Retinal fundus photograph.
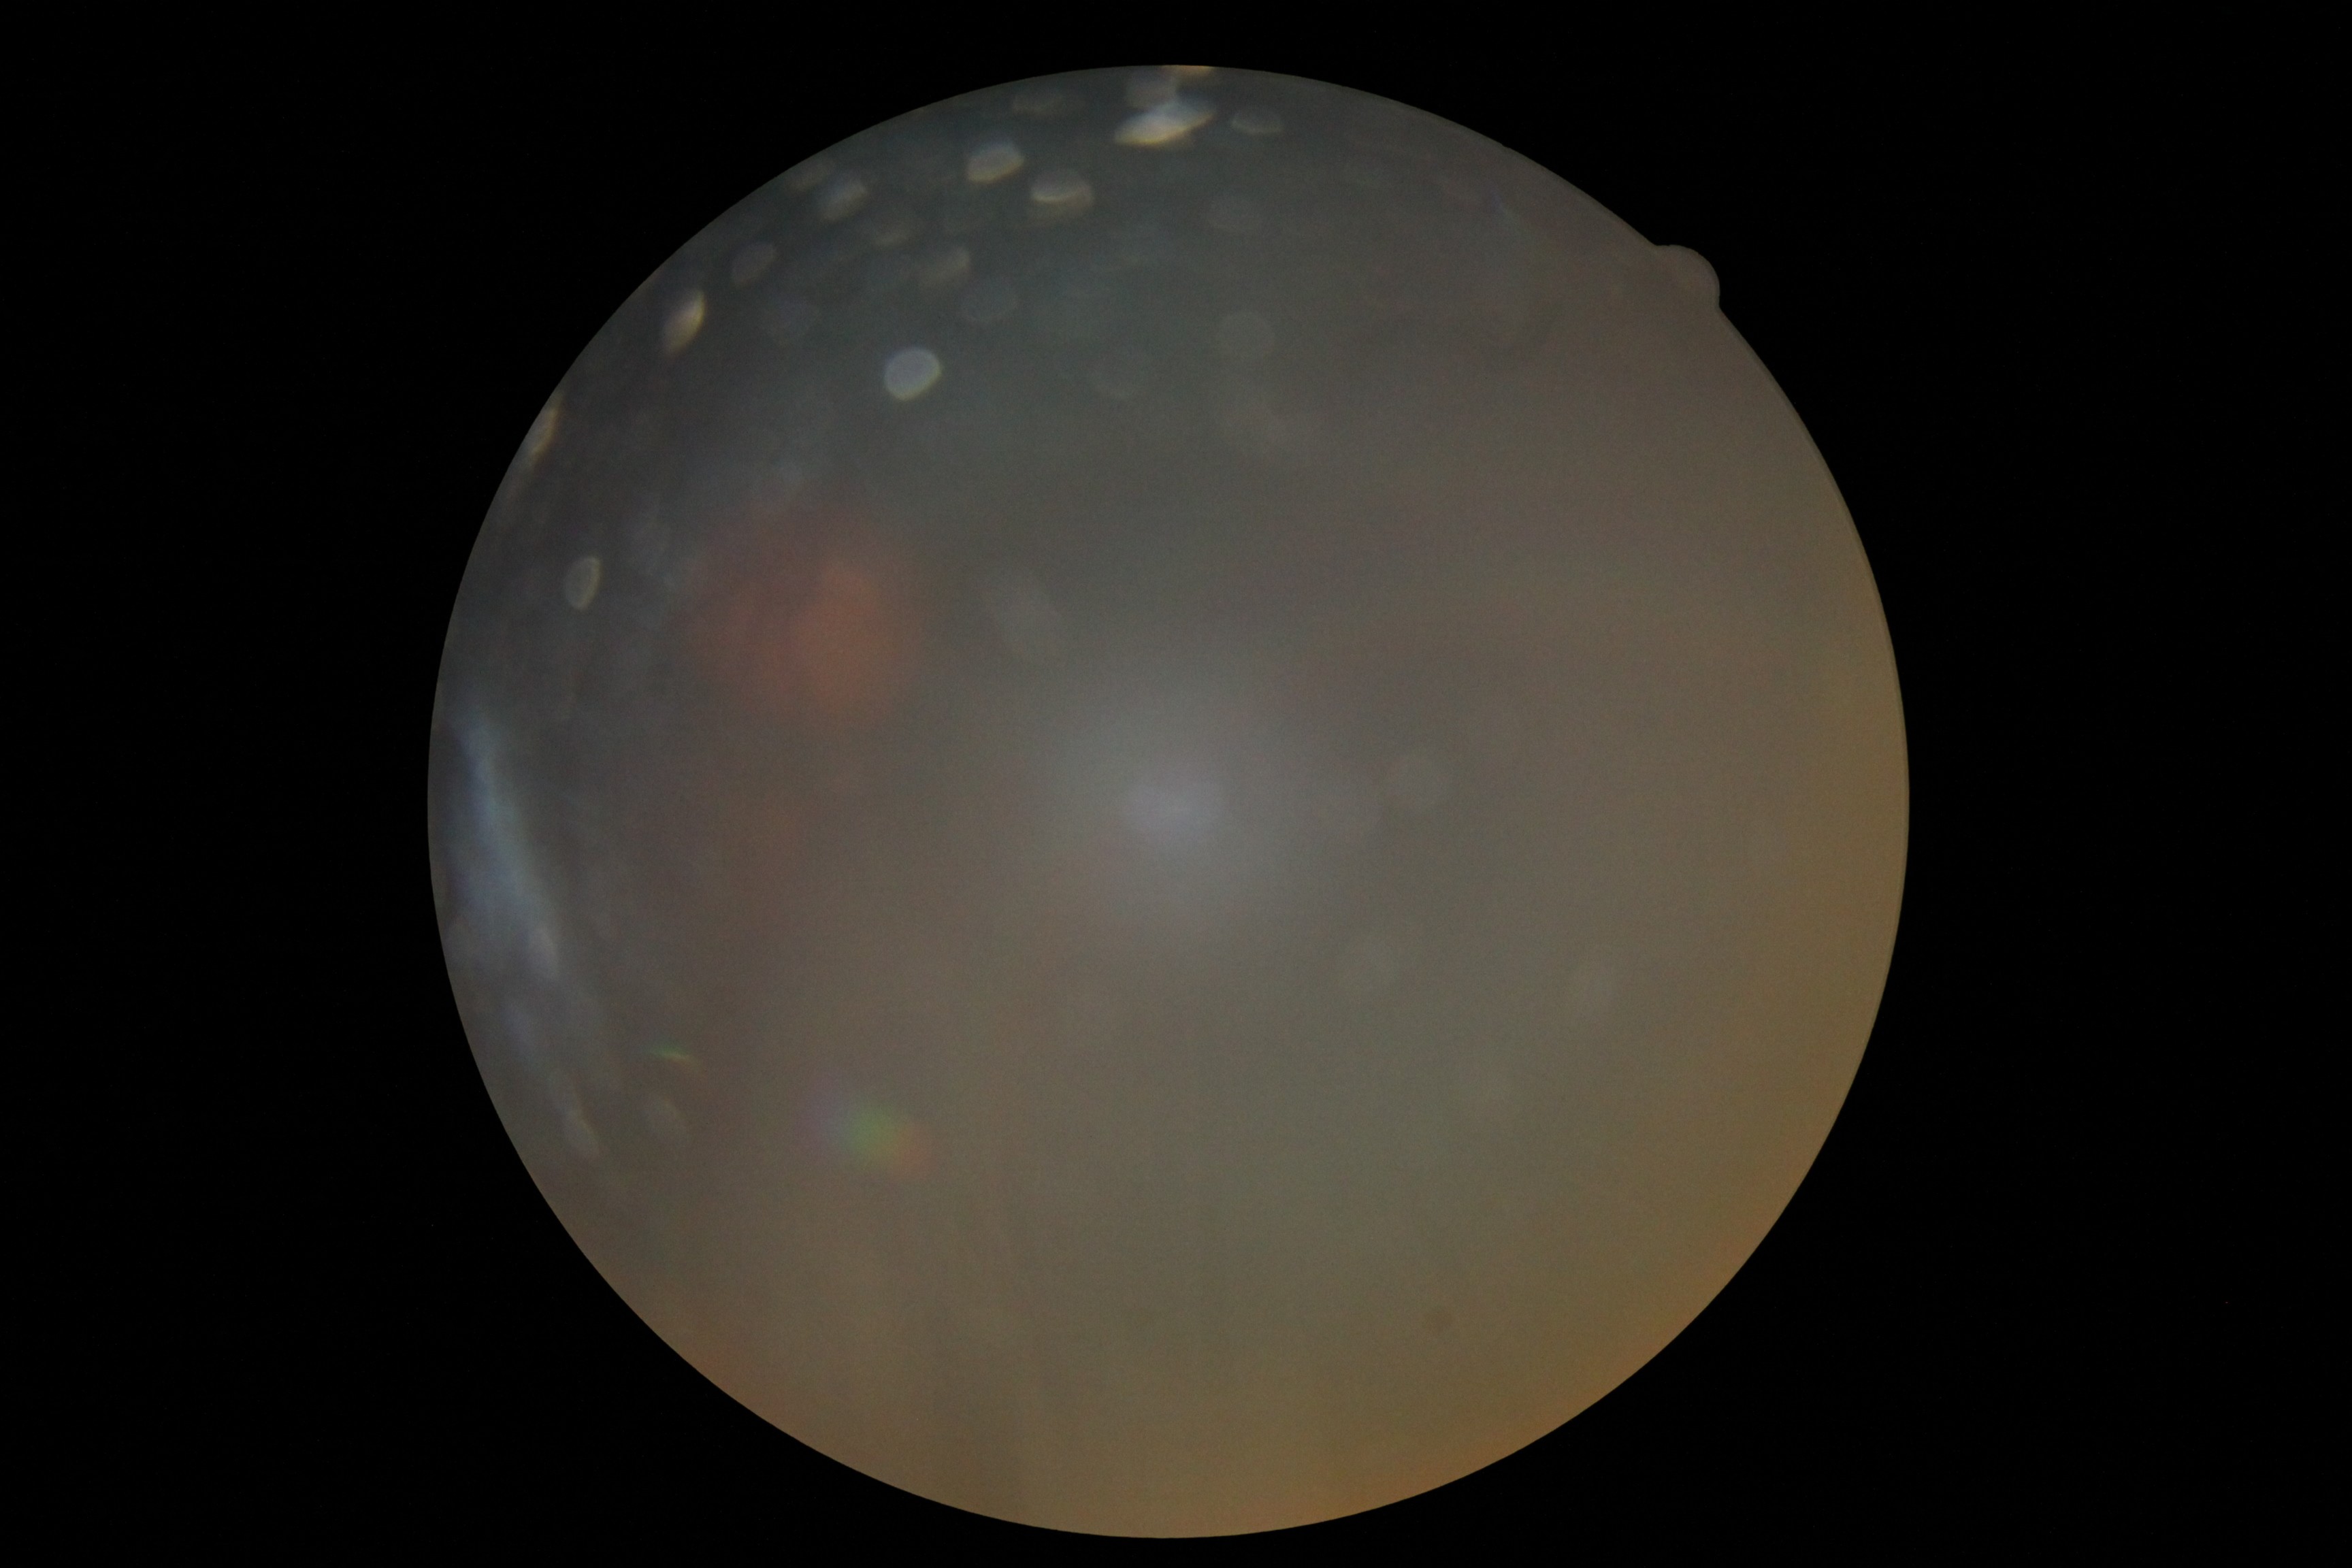

Diabetic retinopathy (DR): ungradable due to poor image quality. Quality too poor to assess for DR.